Wide-field contact fundus photograph of an infant · 640x480px · camera: Clarity RetCam 3 (130° FOV): 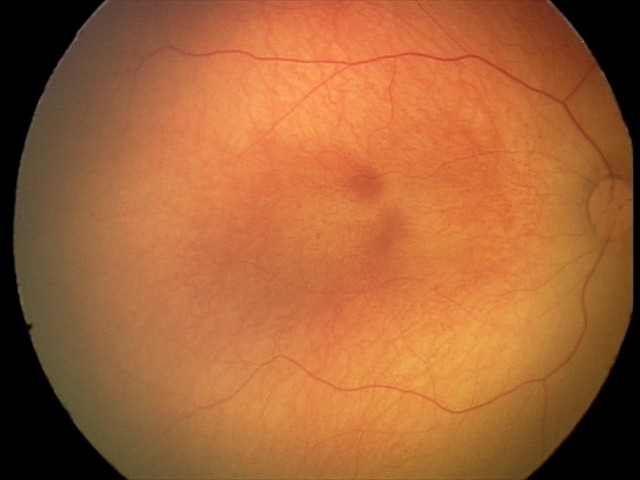 Physiological retinal appearance for postconceptual age.